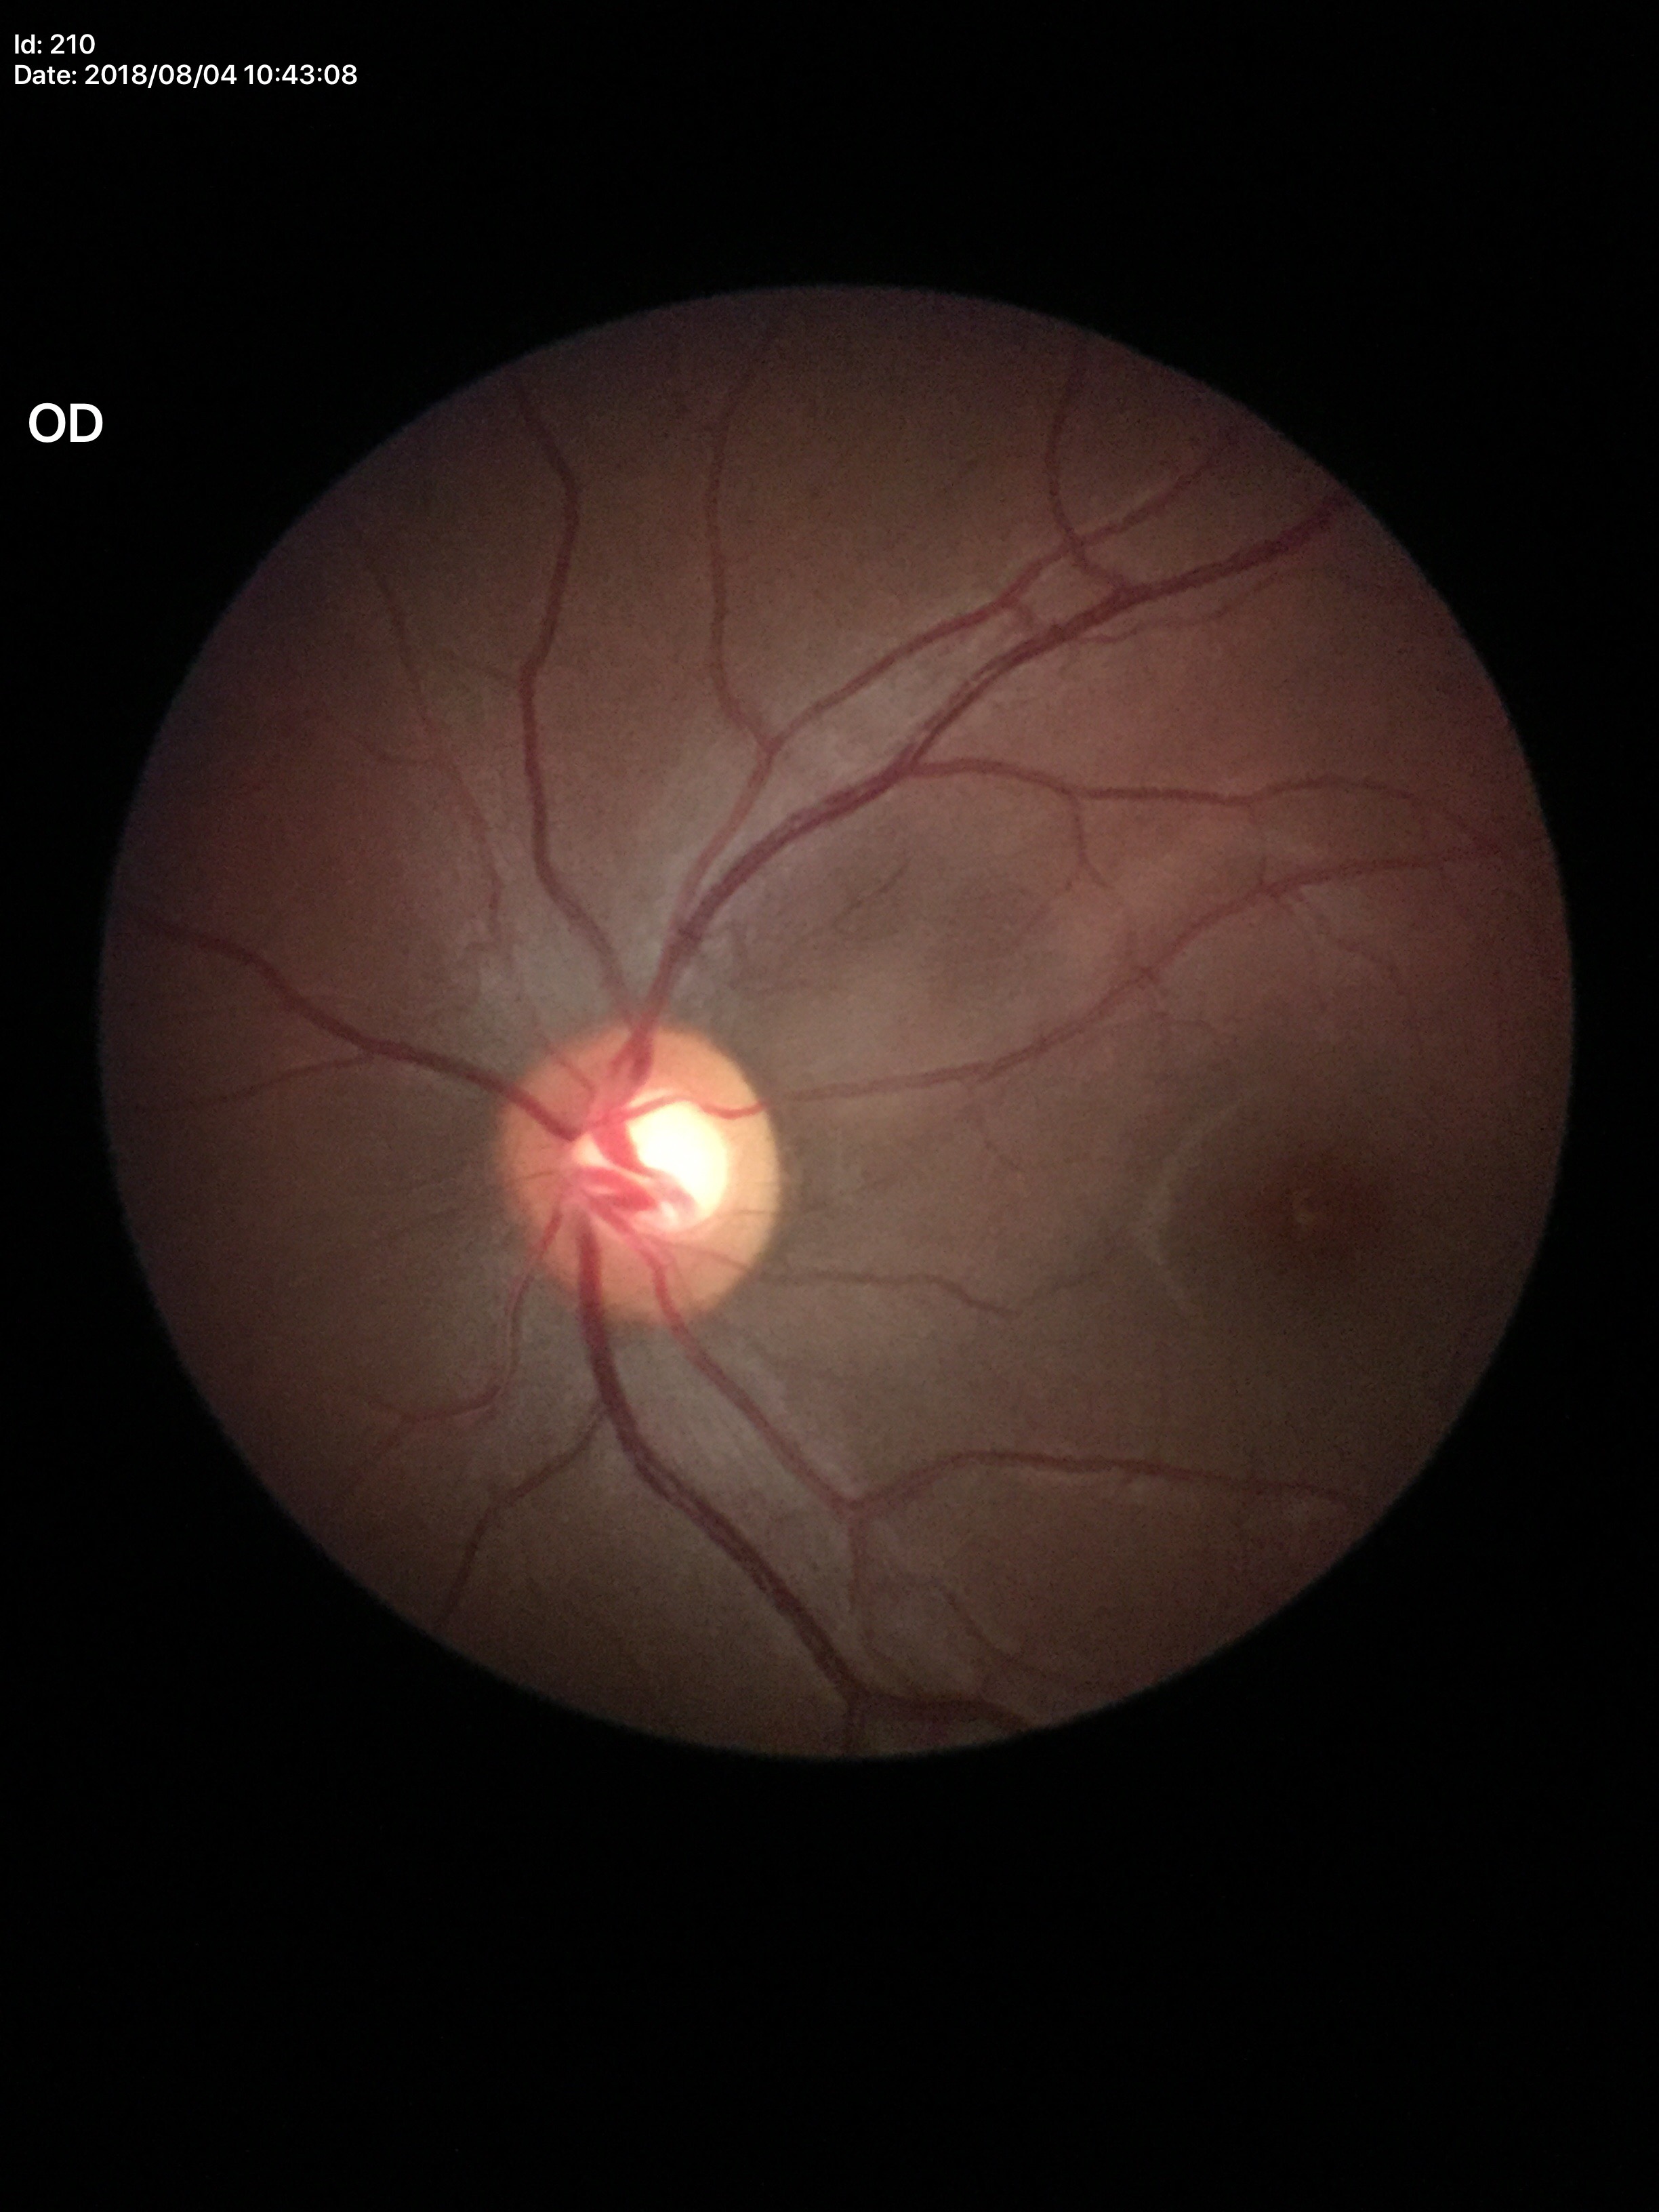
{"glaucoma_decision": "negative", "vcdr": "0.54"}